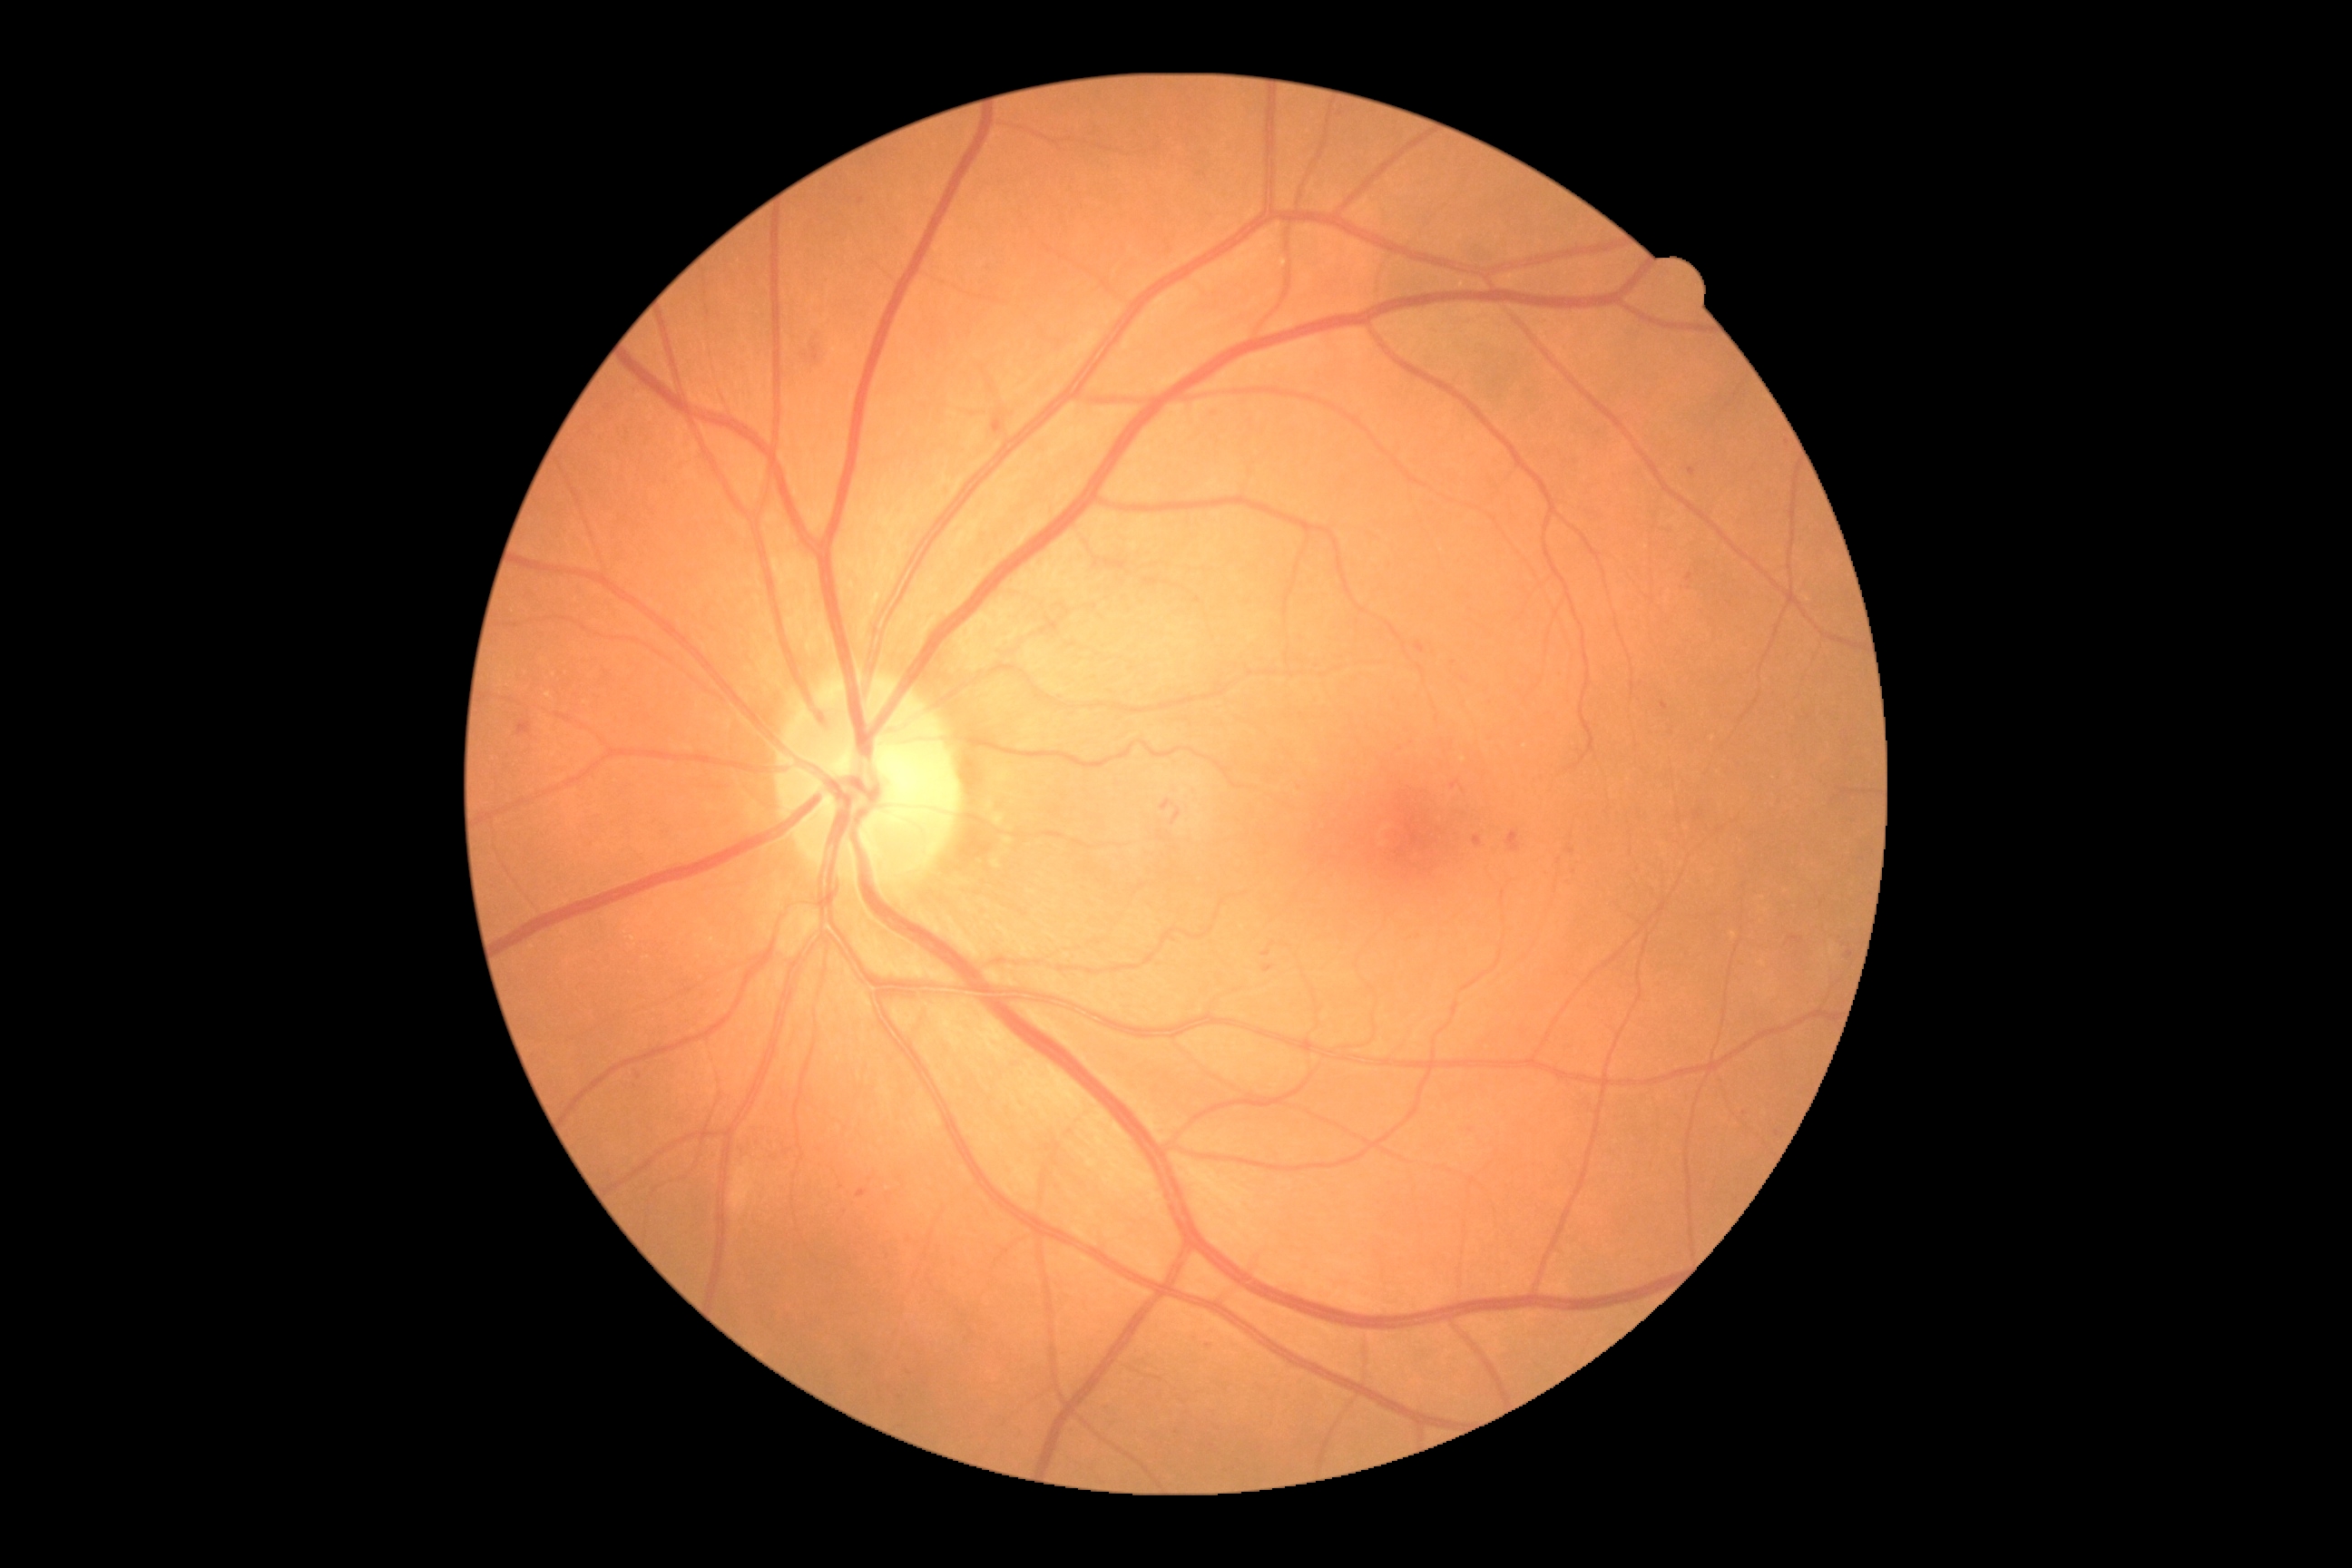
DR grade: 2 — more than just microaneurysms but less than severe NPDR.